Phoenix ICON wide-field infant fundus image; Phoenix ICON, 100° FOV:
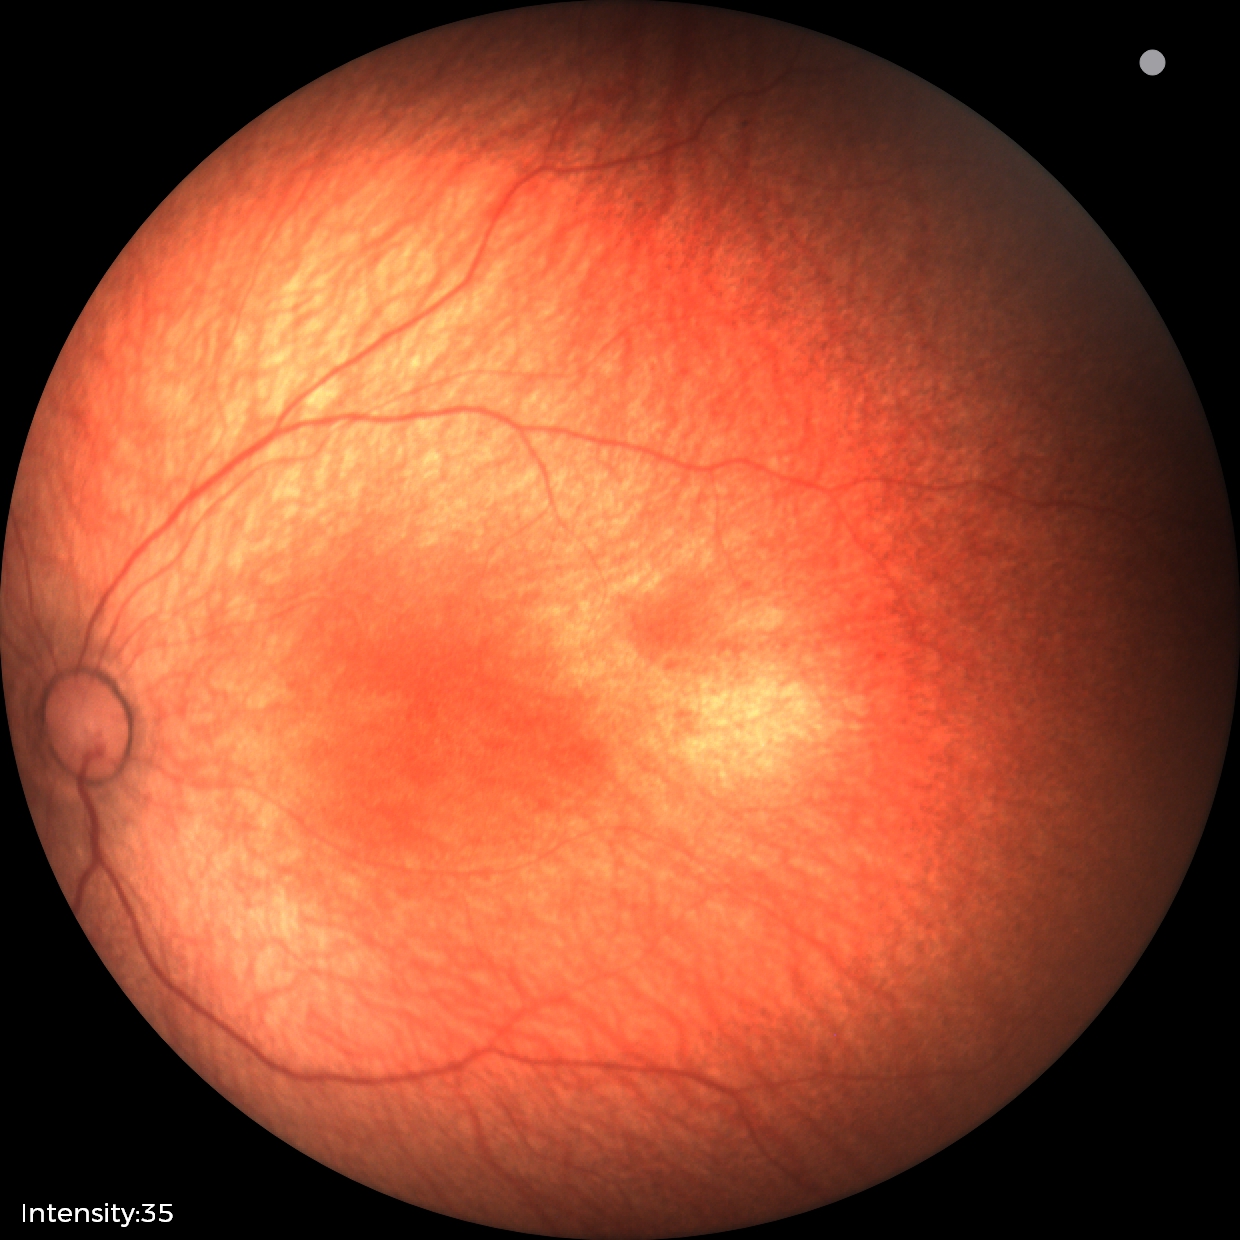 Examination with physiological retinal findings.